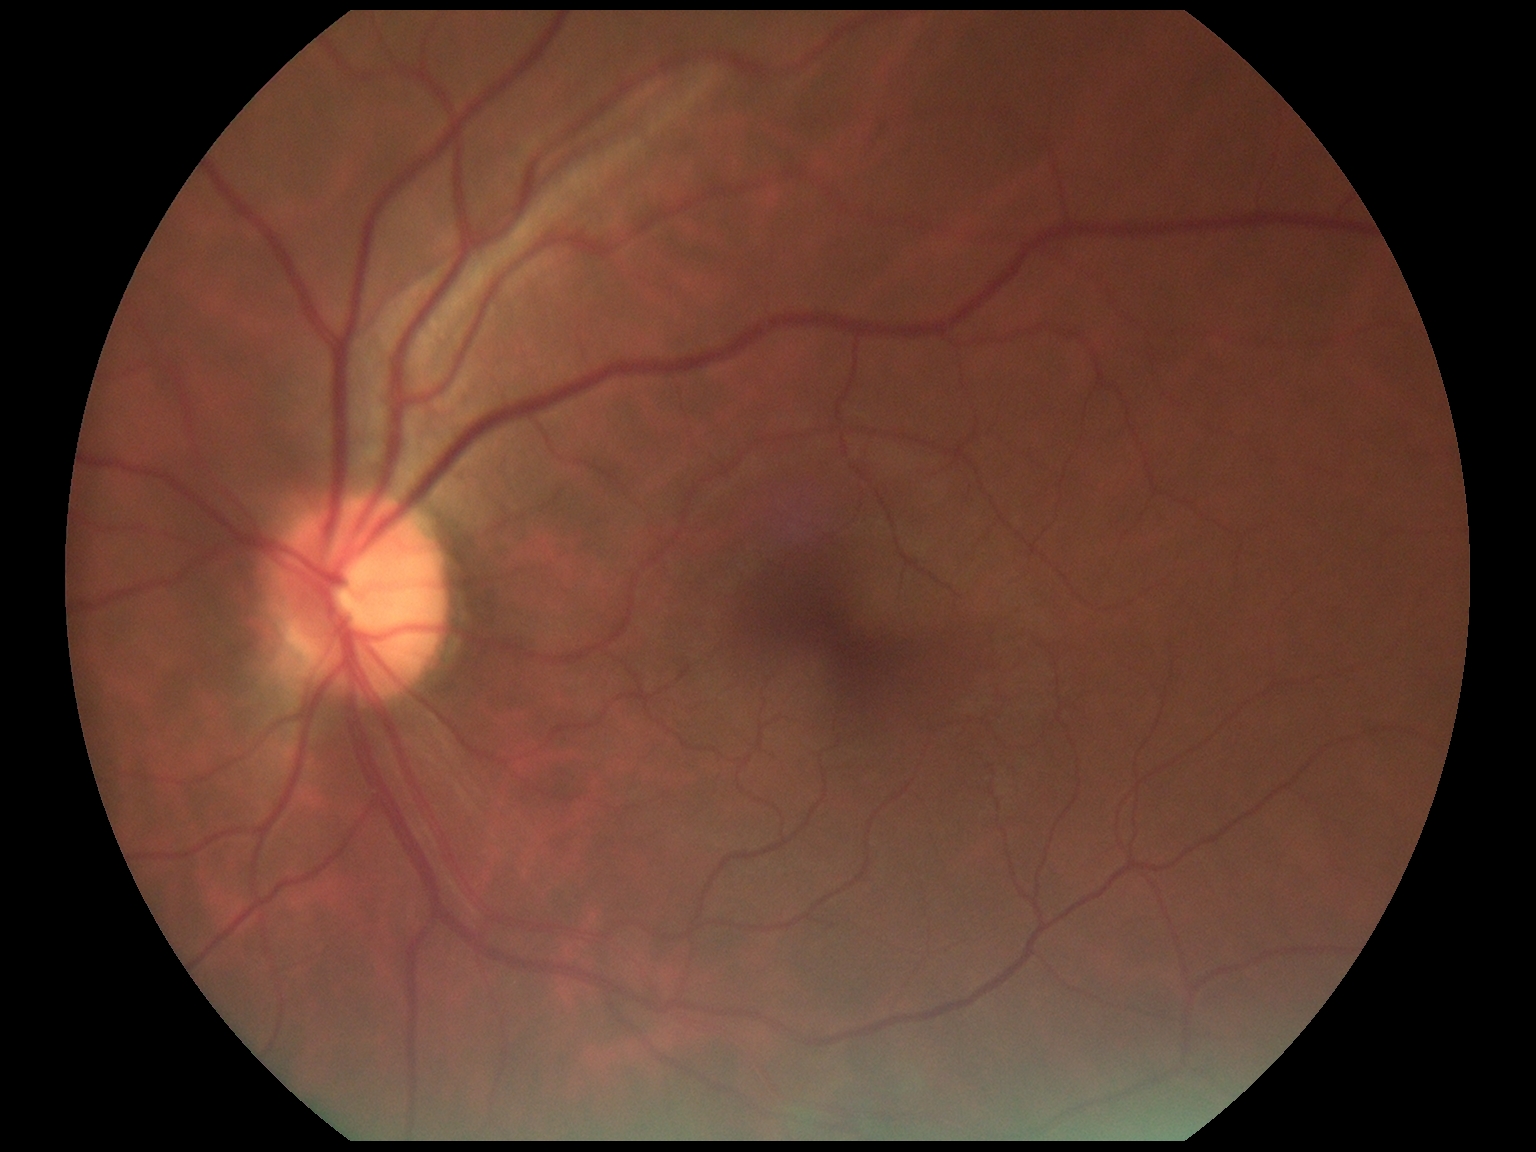

– diabetic retinopathy severity: 0/4 — no visible signs of diabetic retinopathy